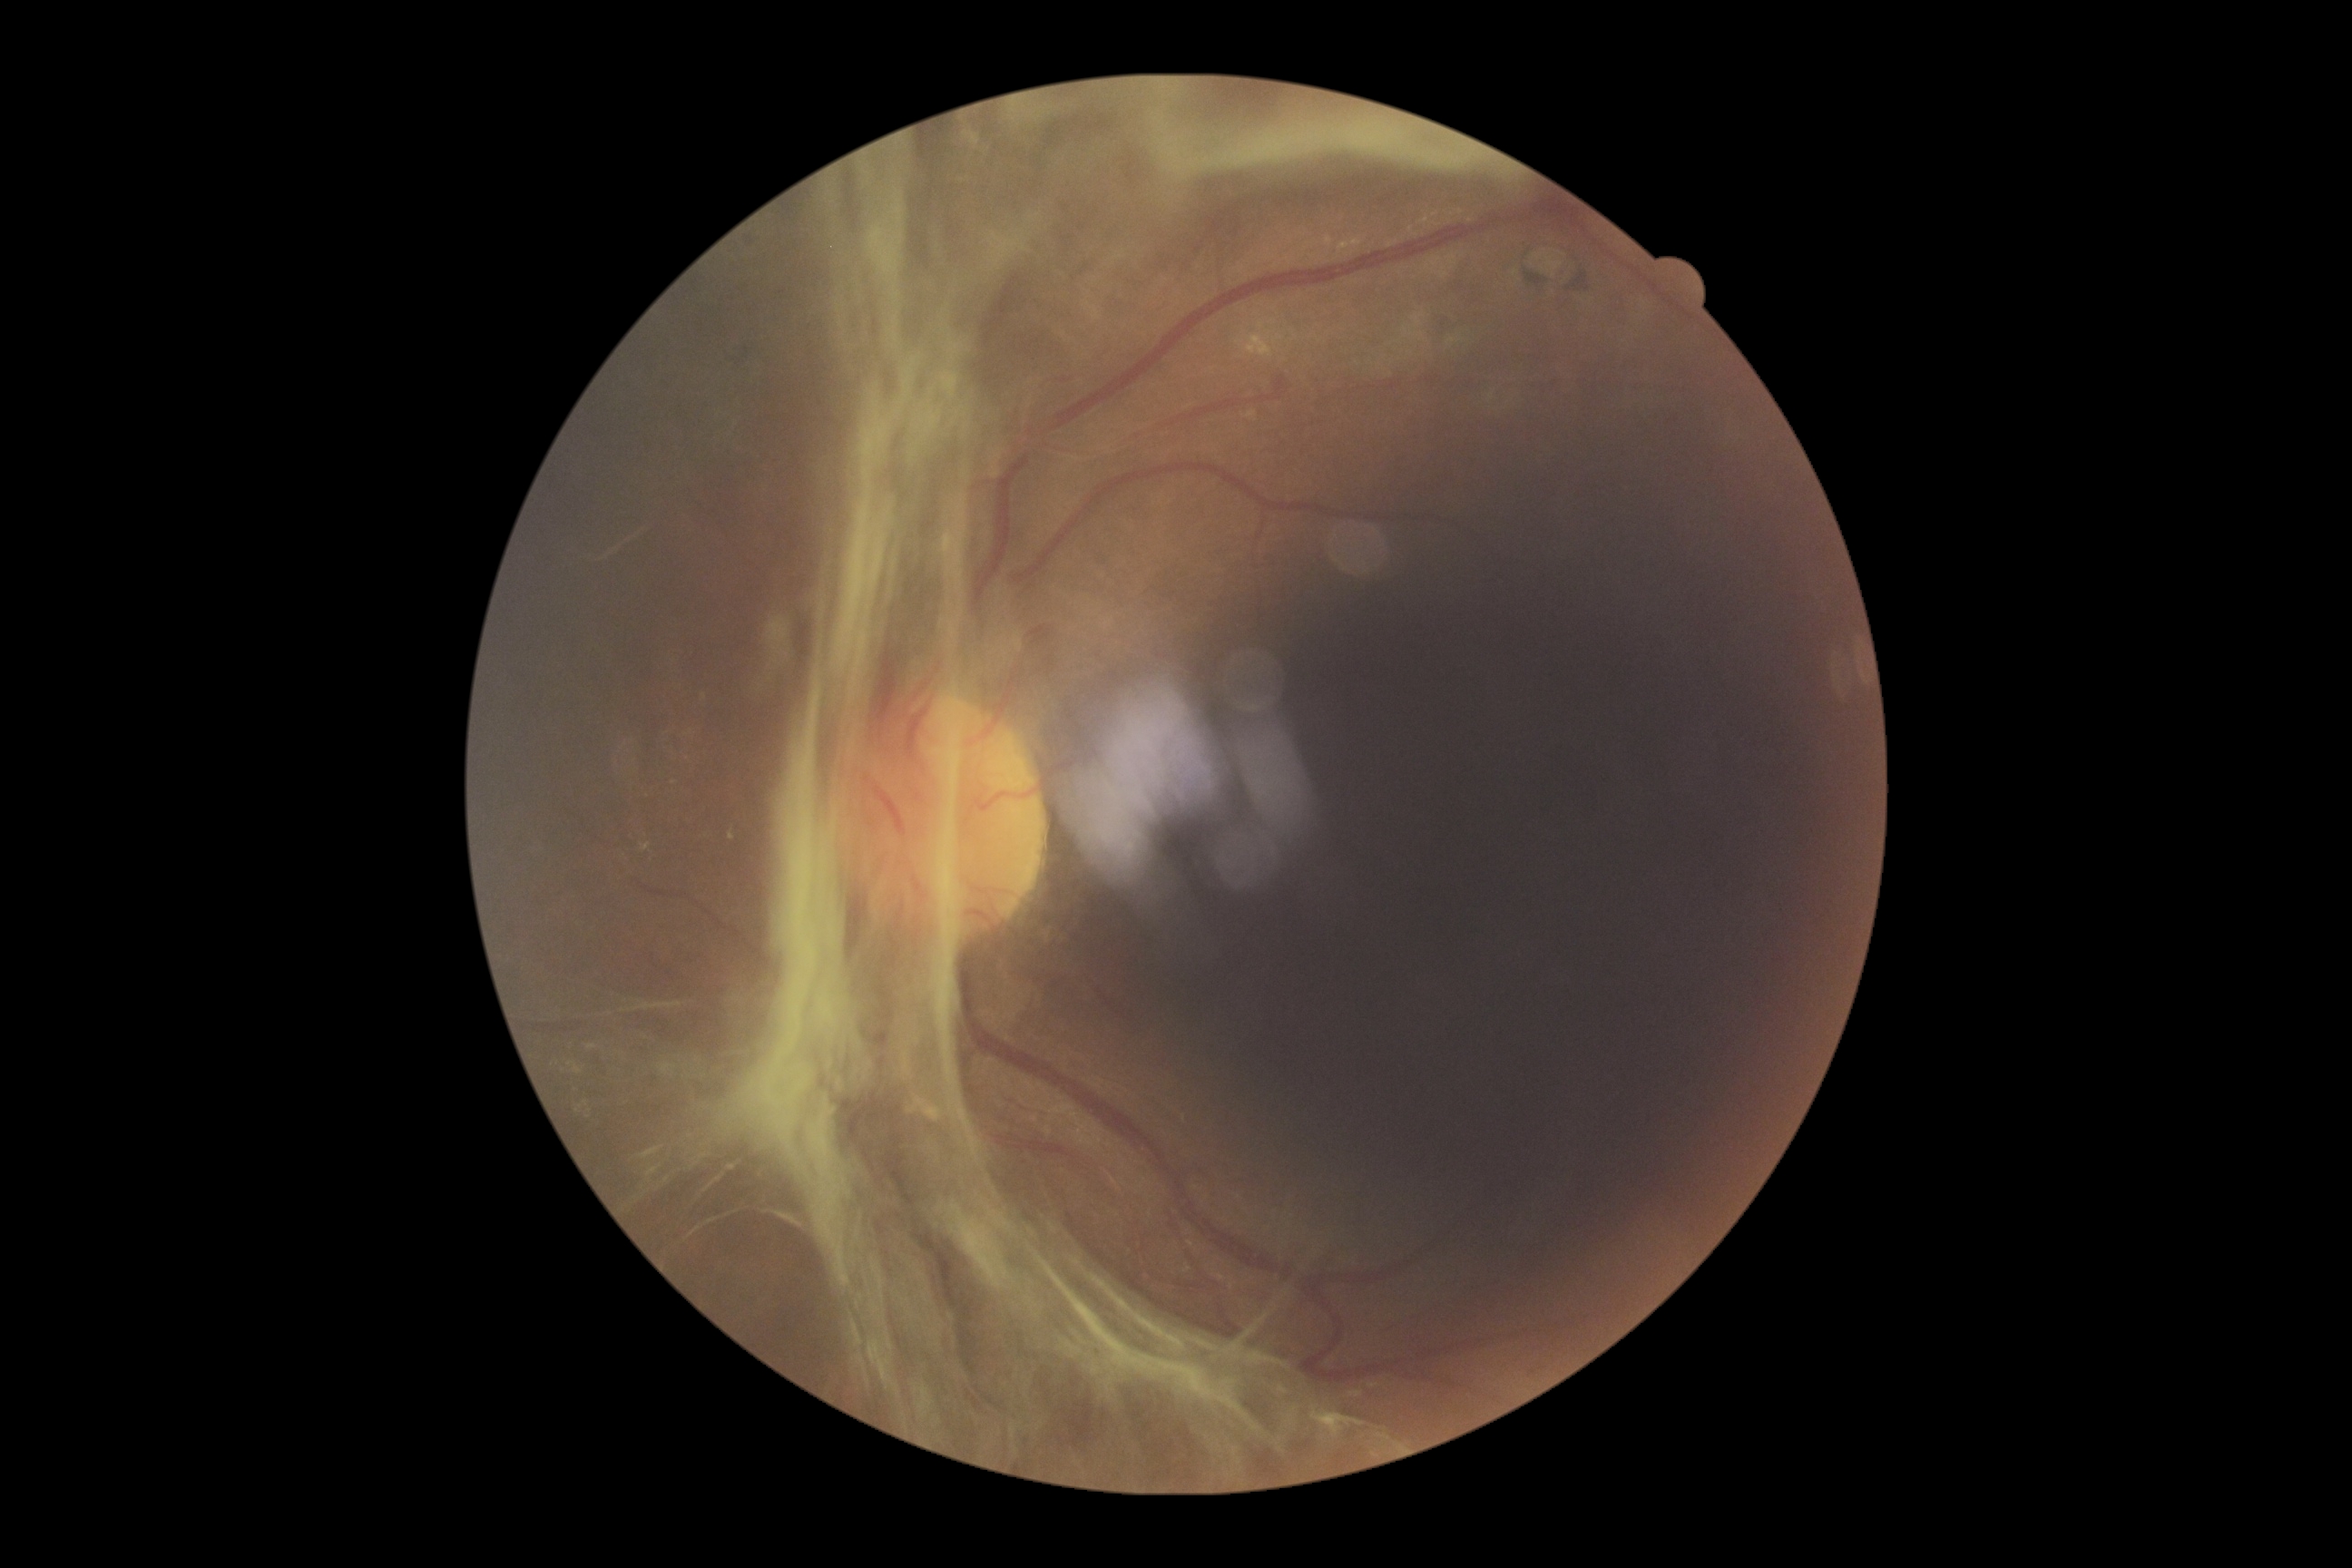
Annotations:
• diabetic retinopathy grade — 4/4
• DR class — proliferative diabetic retinopathy